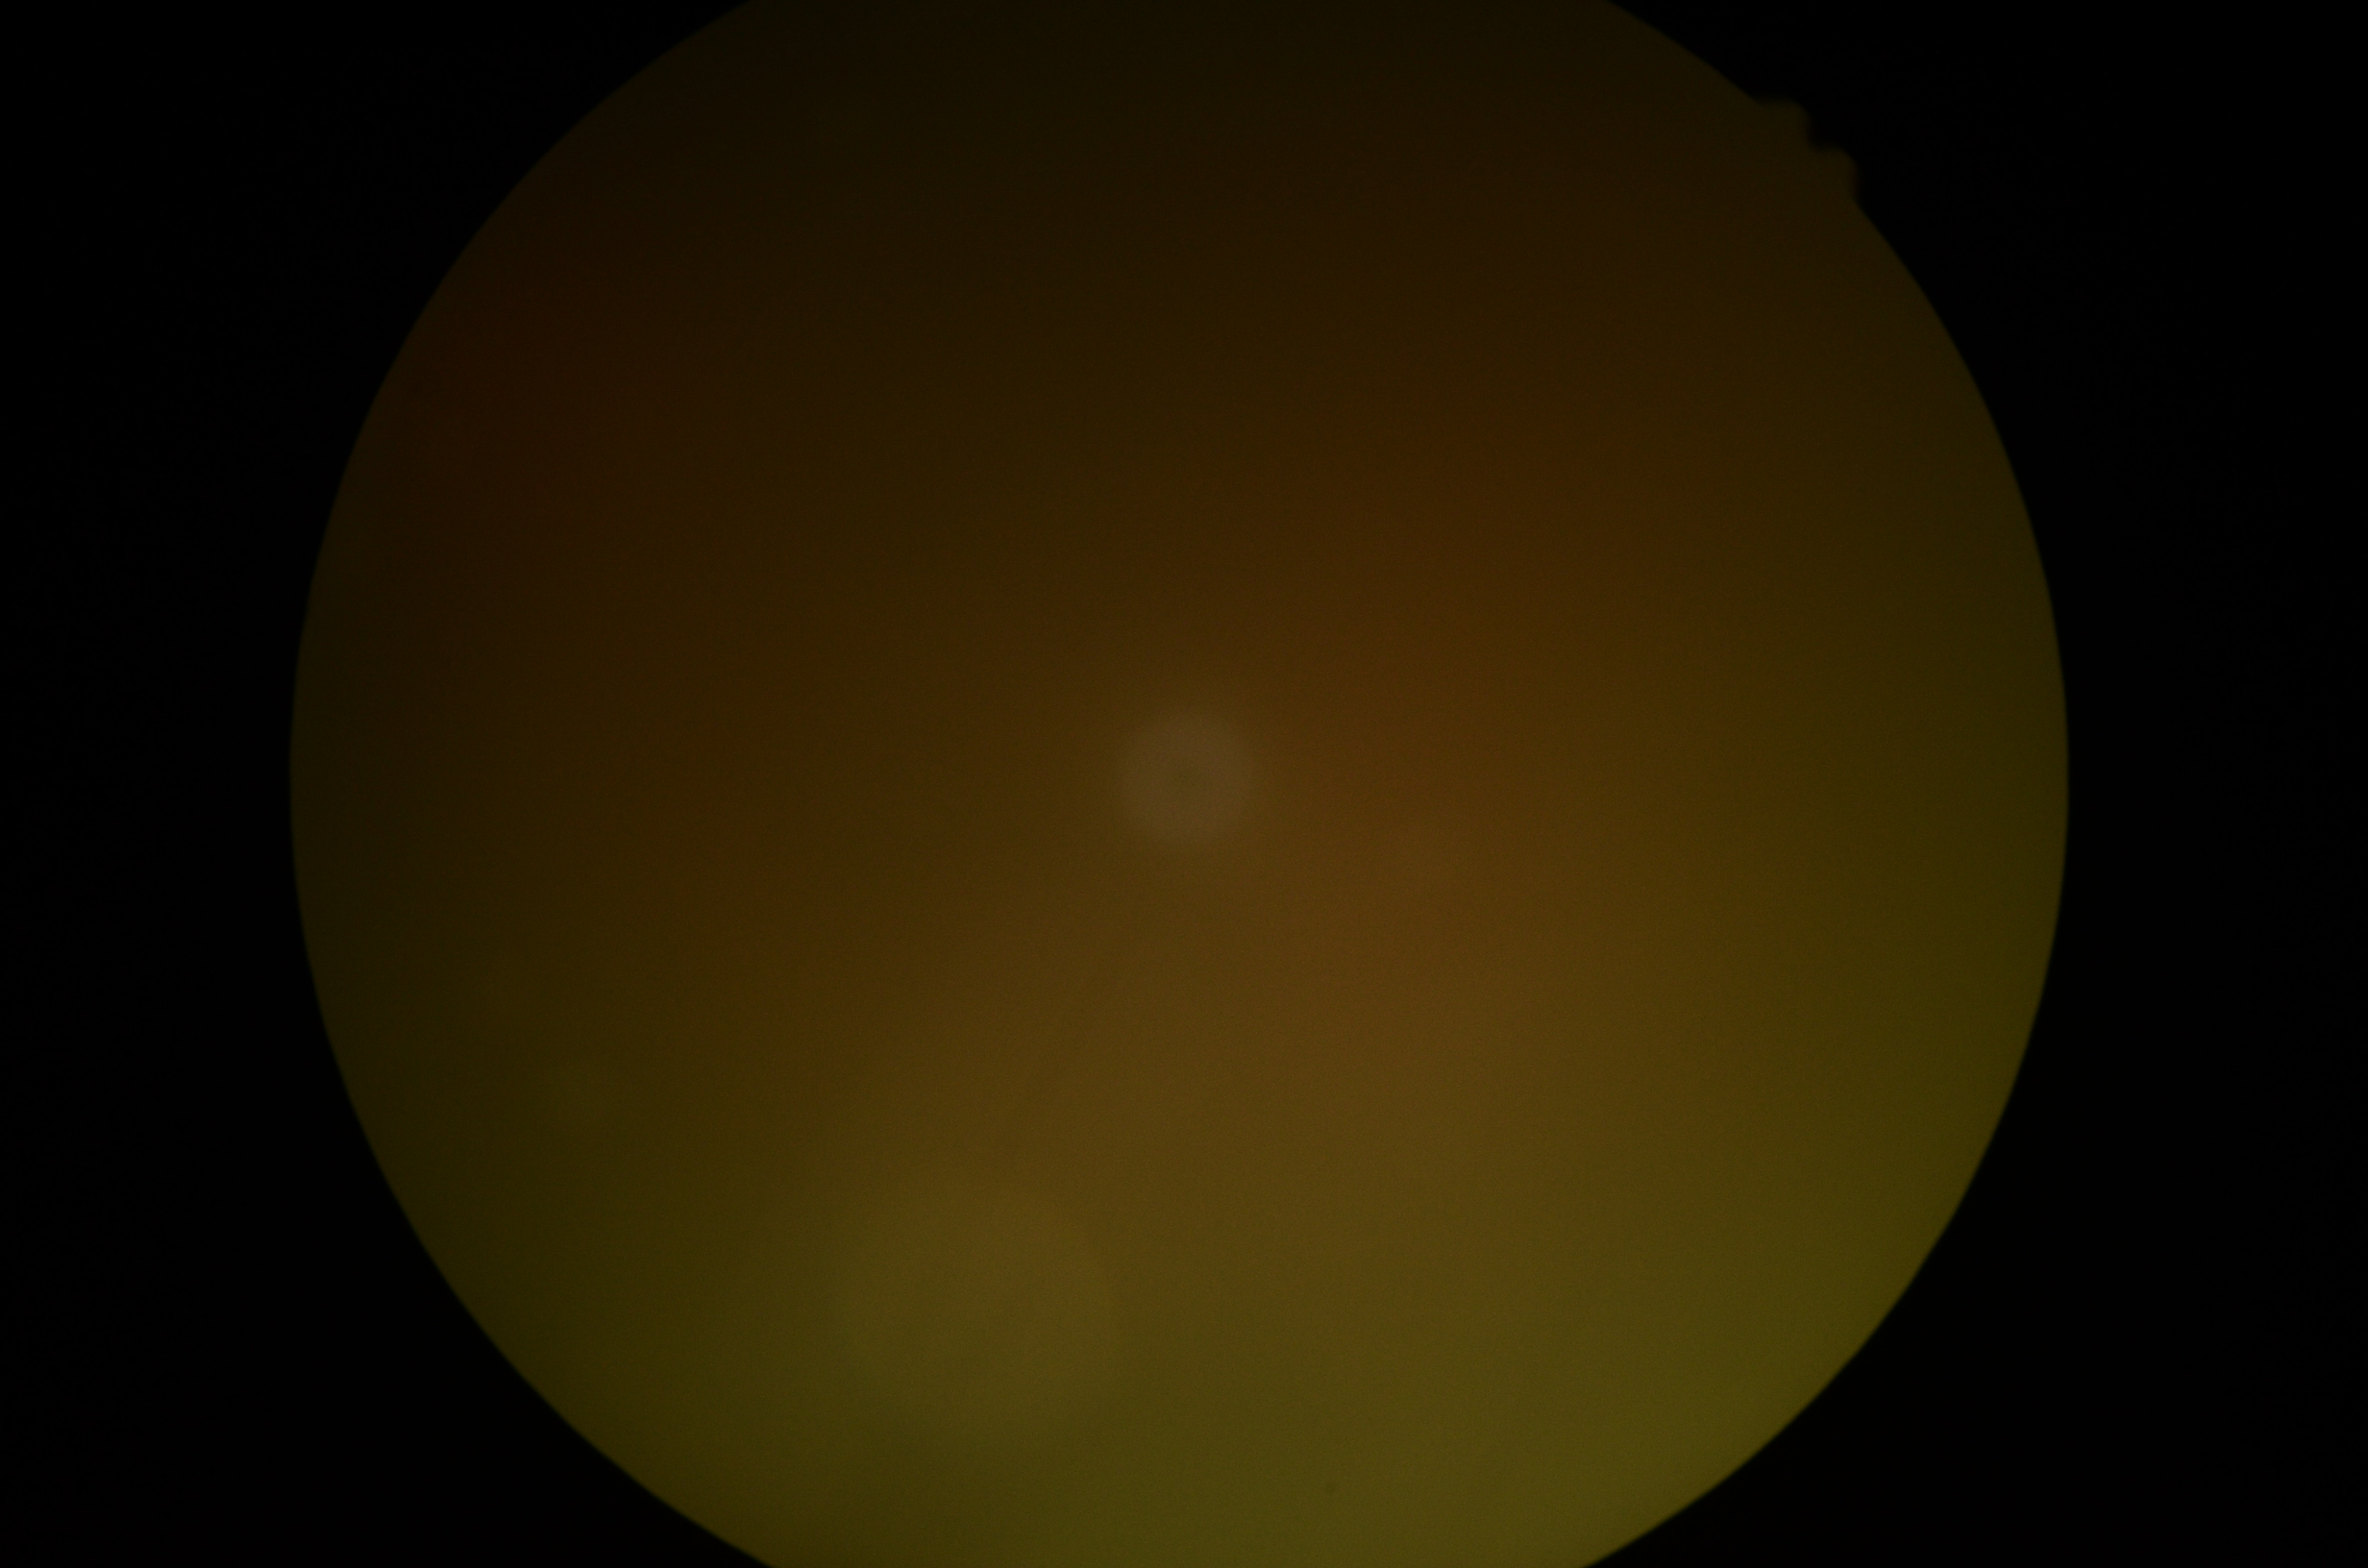
Retinopathy grade: ungradable. Quality too poor to assess for DR.